Pediatric retinal photograph (wide-field) — 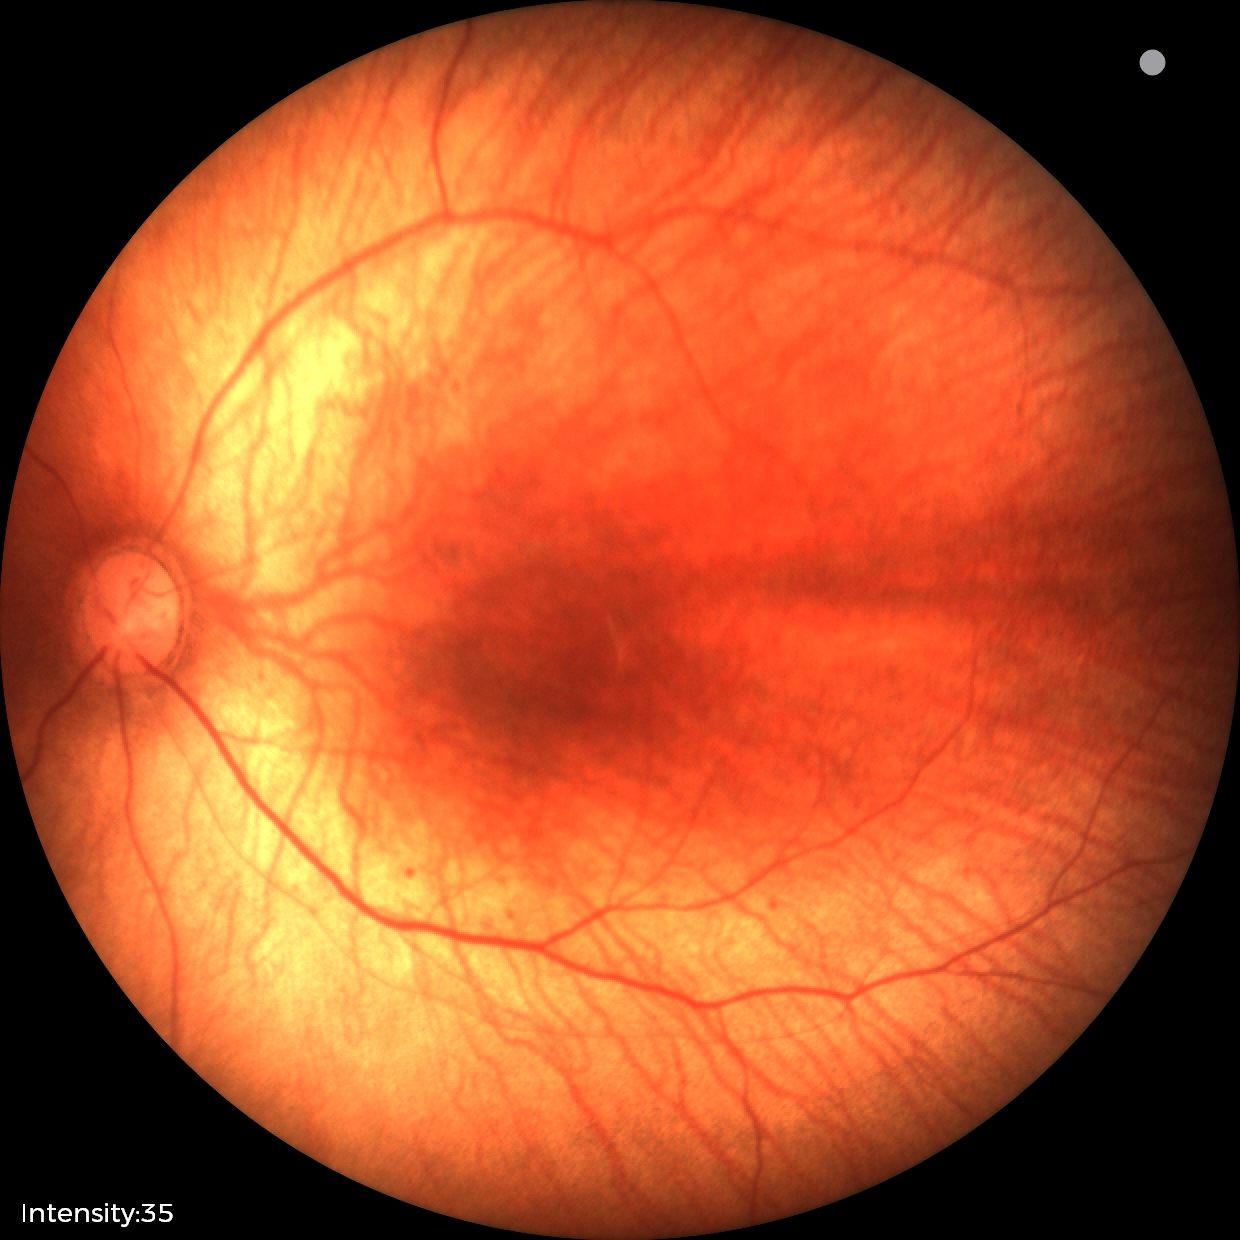 Normal screening examination.